Wide-field fundus photograph of an infant: 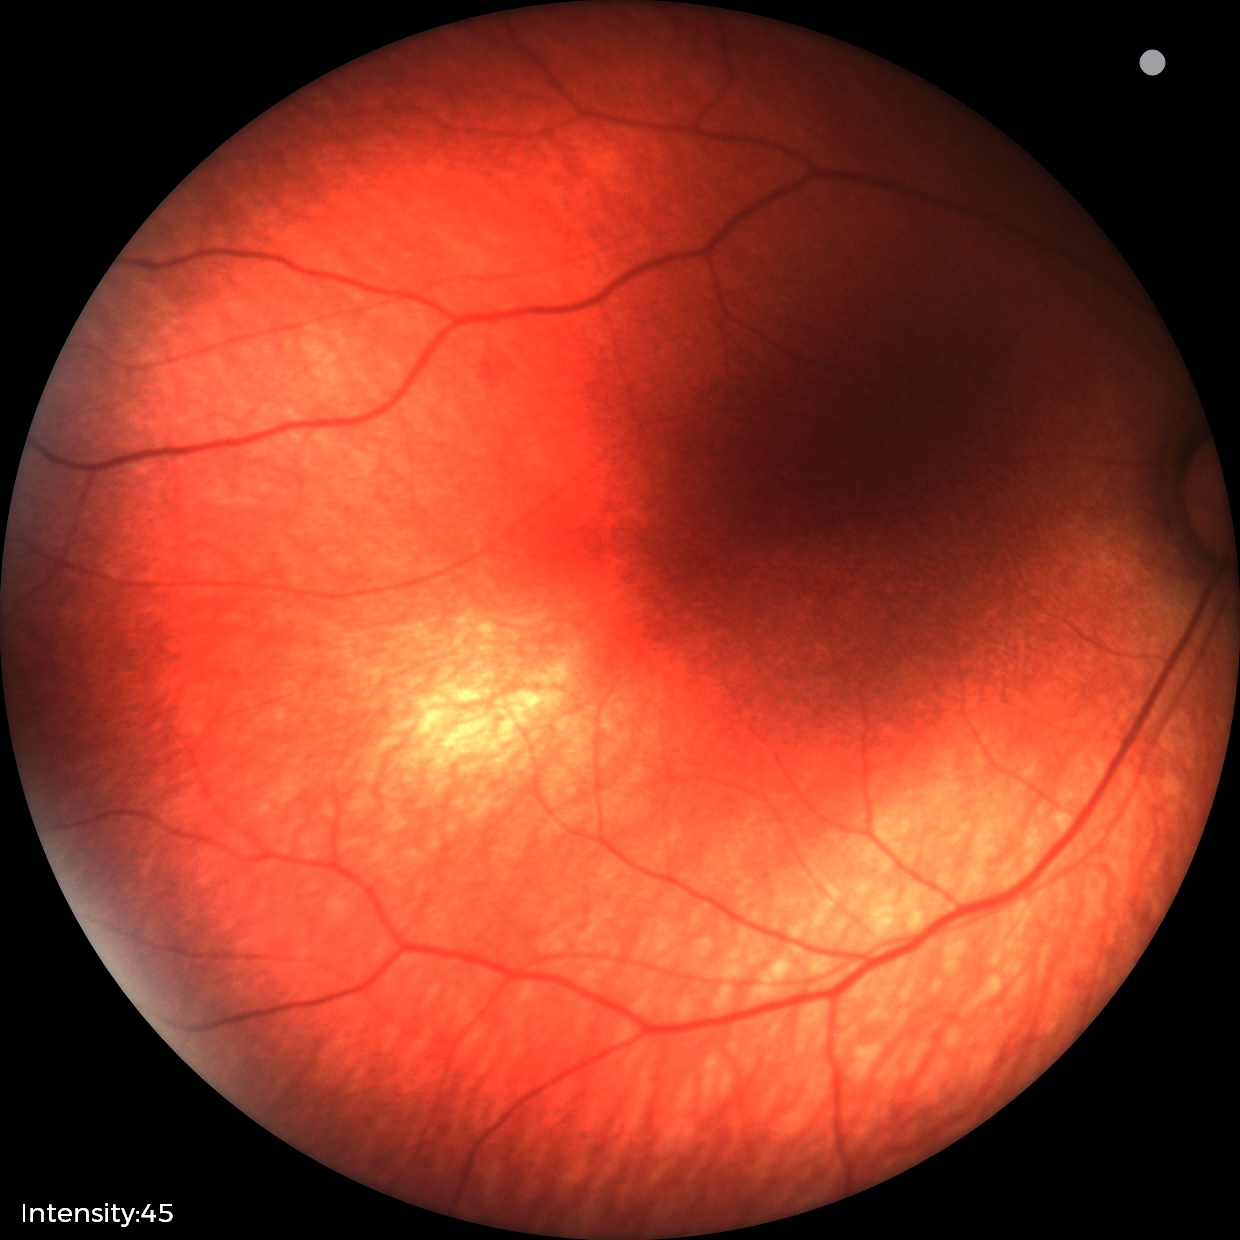 Finding: no abnormalities.